Wide-field fundus photograph from neonatal ROP screening; captured with the Clarity RetCam 3 (130° field of view).
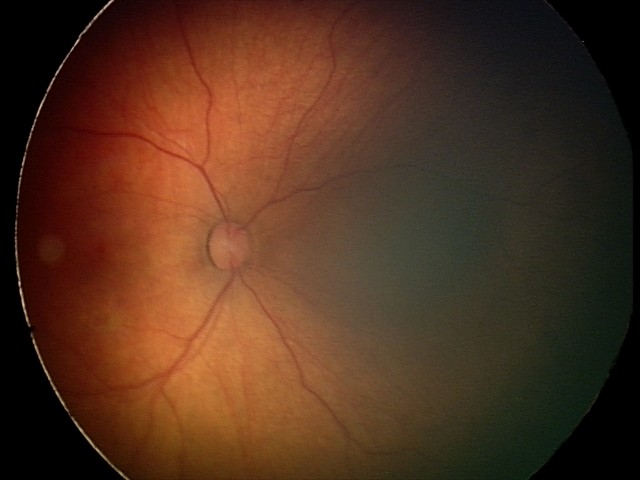

Screening: retinal hemorrhages.